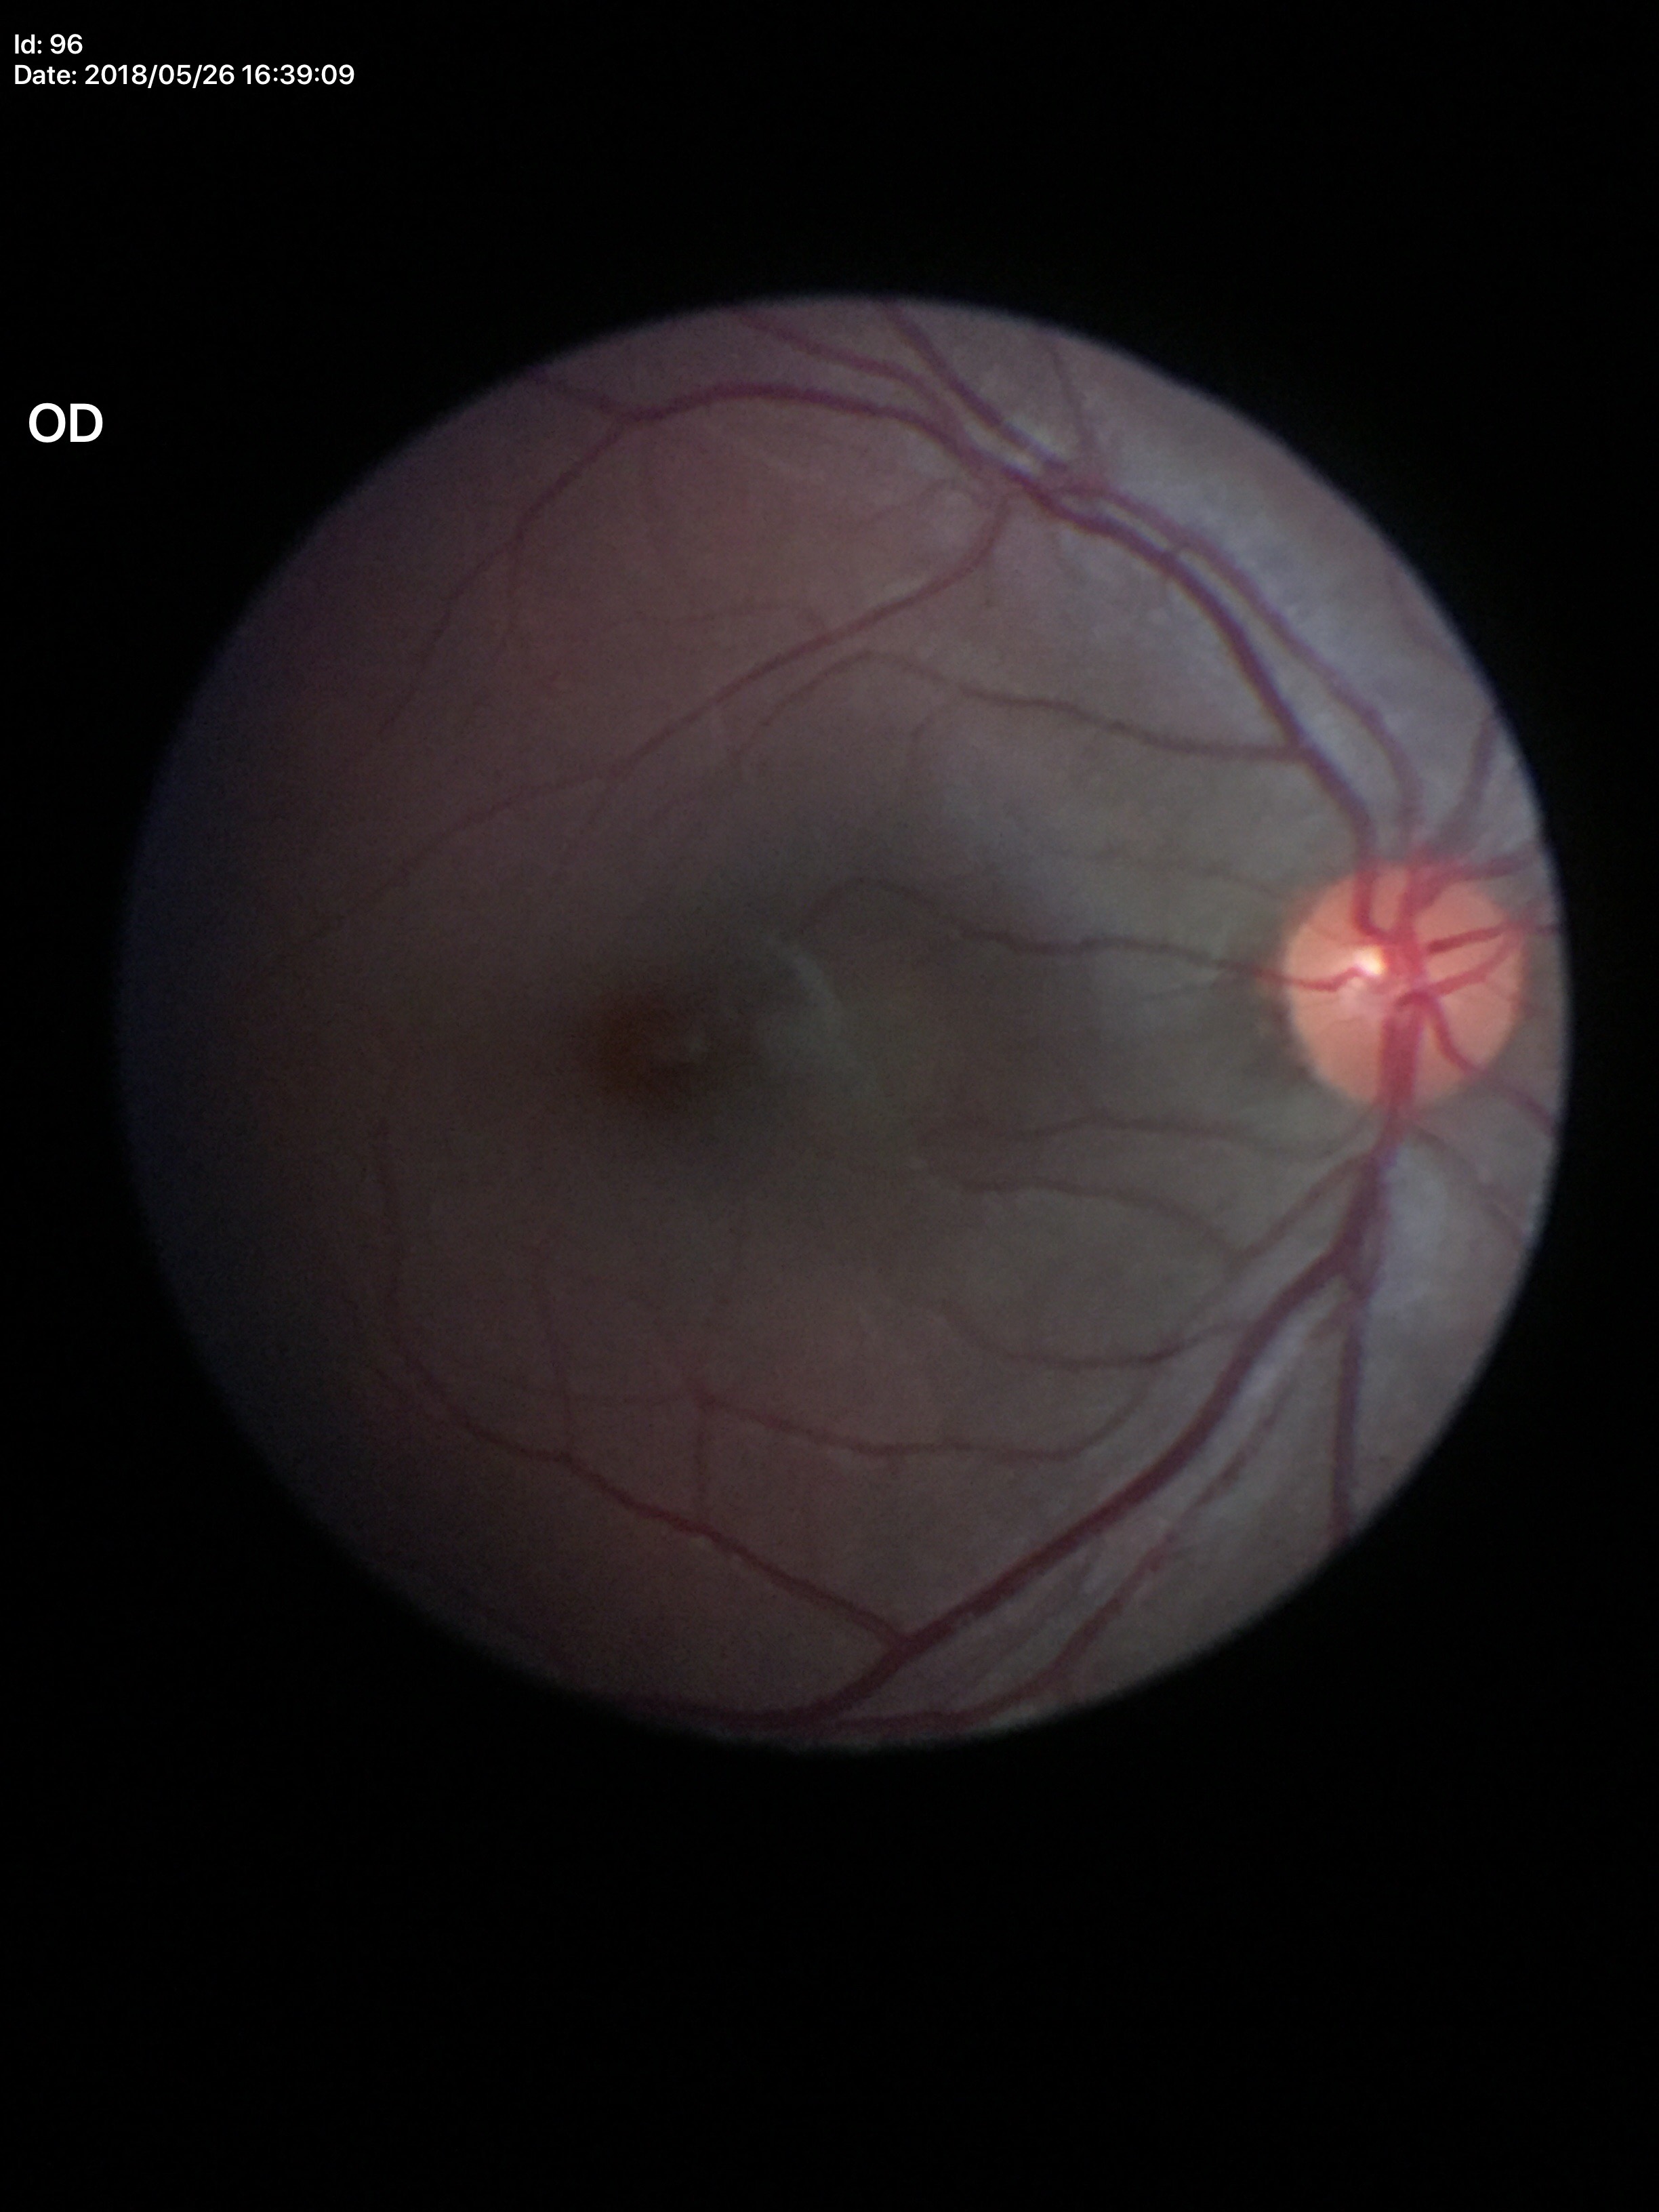 vertical cup-to-disc ratio=0.43 | Glaucoma screening impression=no suspicious findings (all 5 graders called normal)